Pediatric retinal photograph (wide-field) — 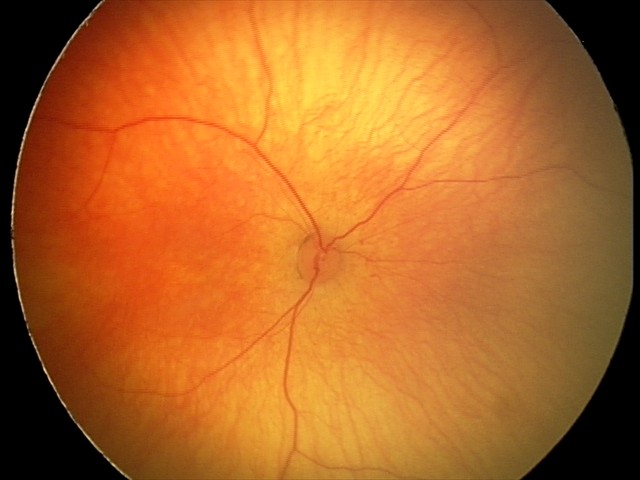 No retinal pathology identified on screening.